Captured without pupil dilation; color fundus photograph — 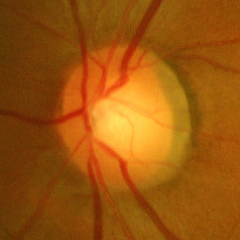
Glaucomatous optic neuropathy is present. Demonstrates advanced-stage glaucoma.